45° field of view; fundus photo
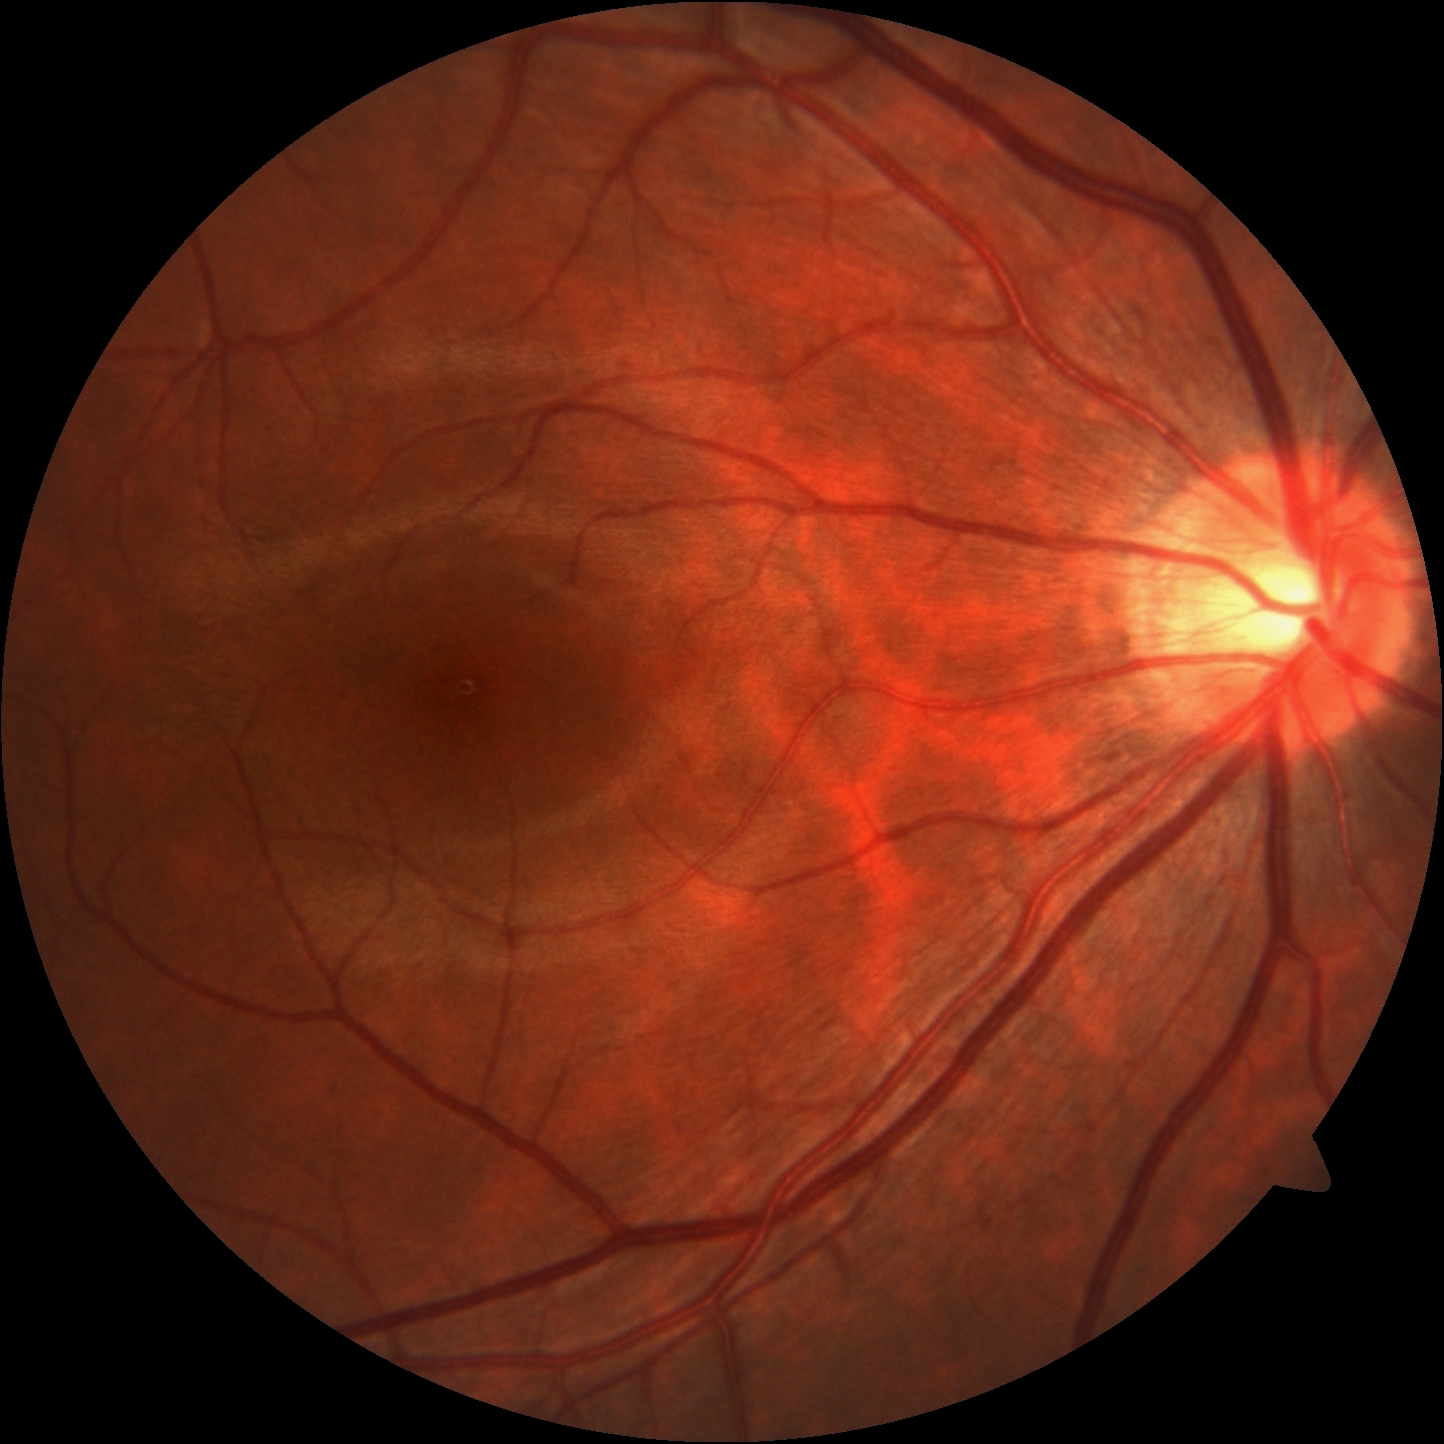 {
  "dr_grade": "0/4"
}